Camera: NIDEK AFC-230: 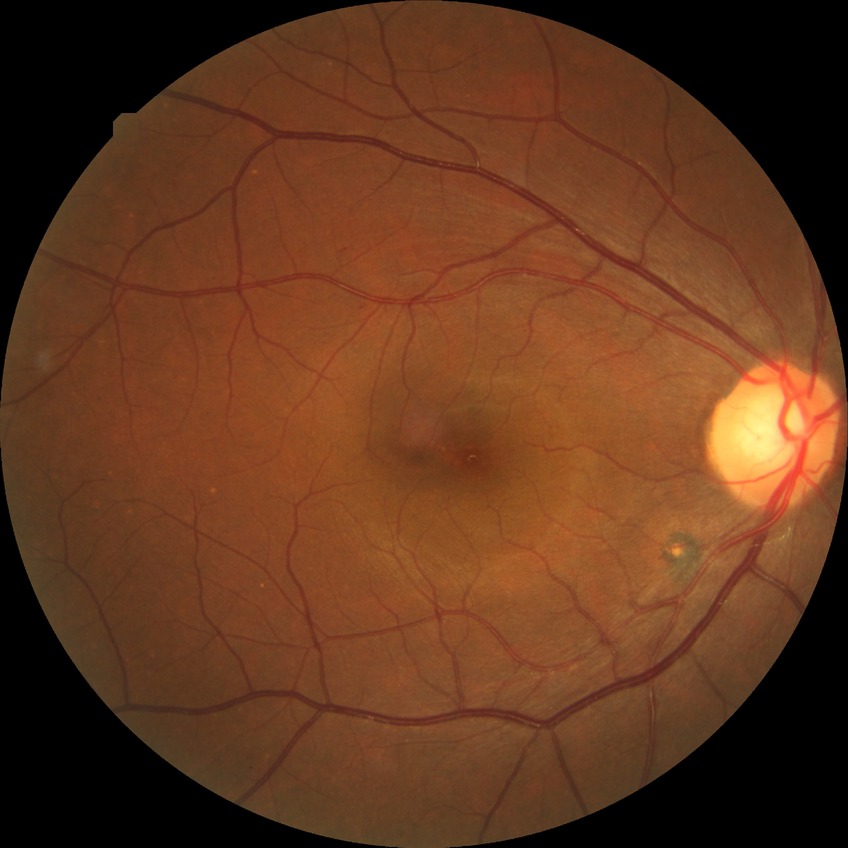
diabetic retinopathy (DR)=NDR (no diabetic retinopathy).